Image size 848x848; NIDEK AFC-230 fundus camera: 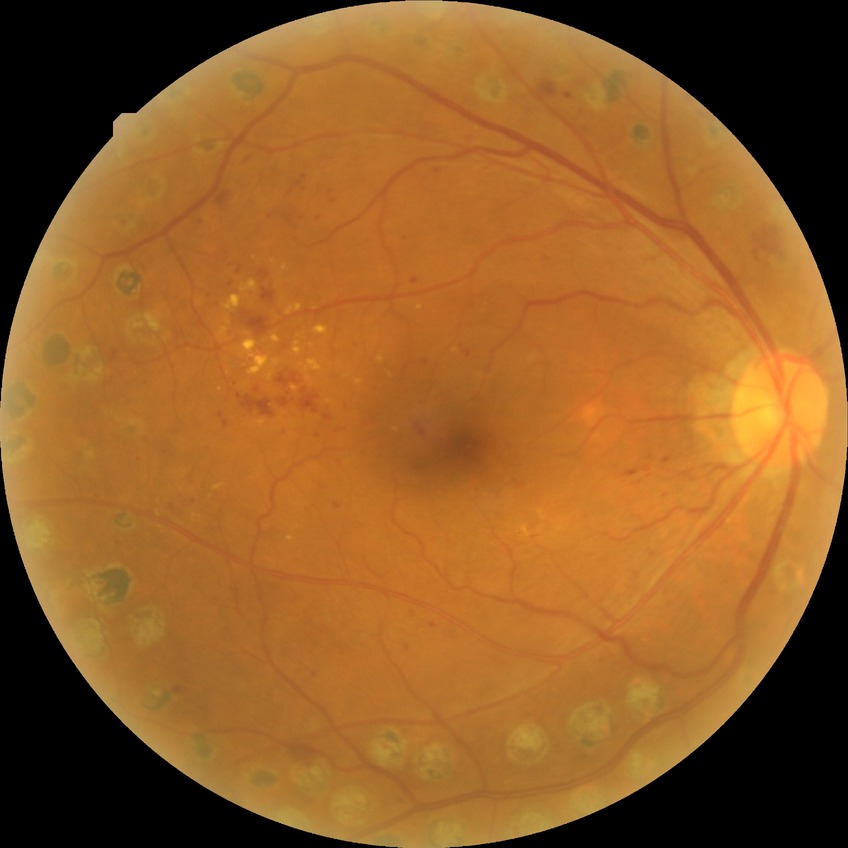

Assessment:
• Davis stage: PDR